RetCam wide-field infant fundus image
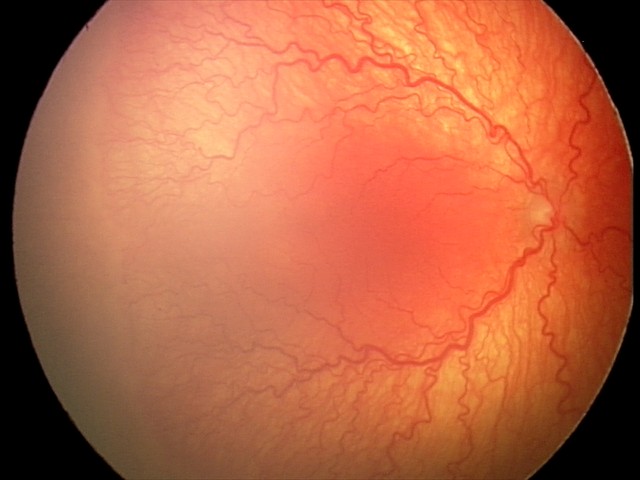

Q: What is the diagnosis from this examination?
A: aggressive retinopathy of prematurity
Q: Is plus disease present?
A: plus disease